Nonmydriatic fundus photograph — 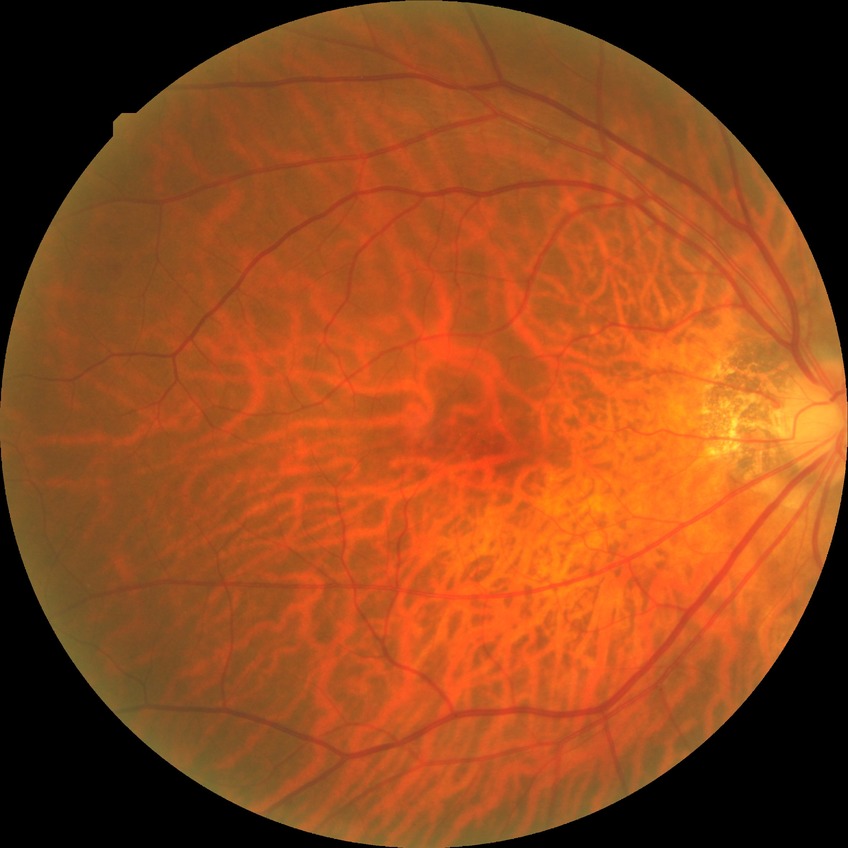

diabetic retinopathy (DR): NDR (no diabetic retinopathy).